Optic disc-centered crop from a color fundus photograph · mydriatic acquisition.
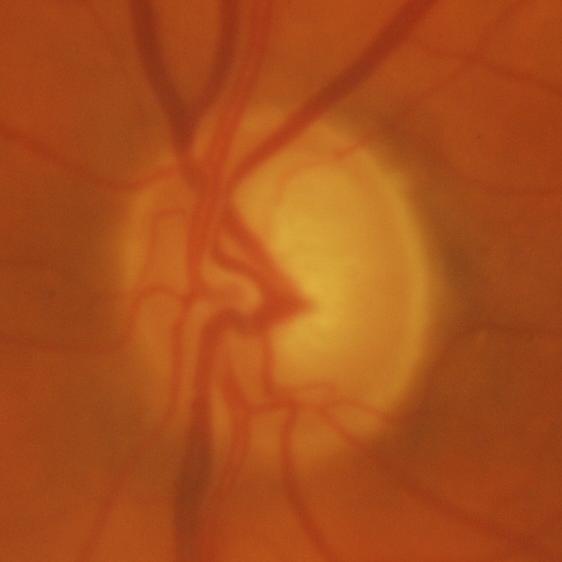

Consistent with glaucomatous changes.